Image size 848x848. Retinal fundus photograph: 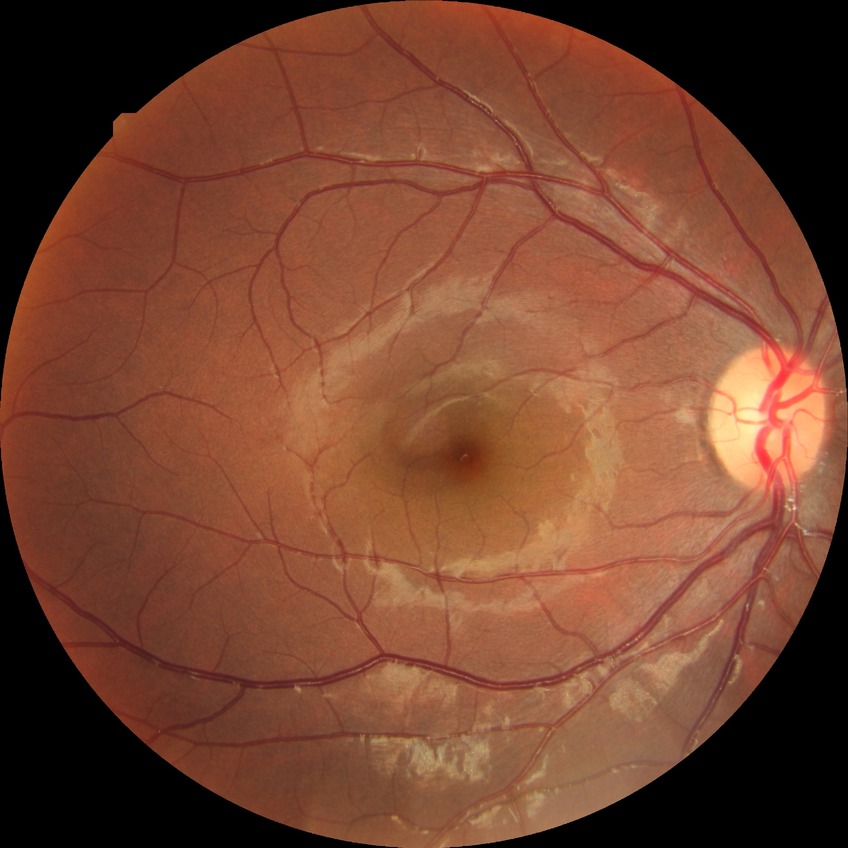
Modified Davis grading is simple diabetic retinopathy.